Davis DR grading. 45° field of view: 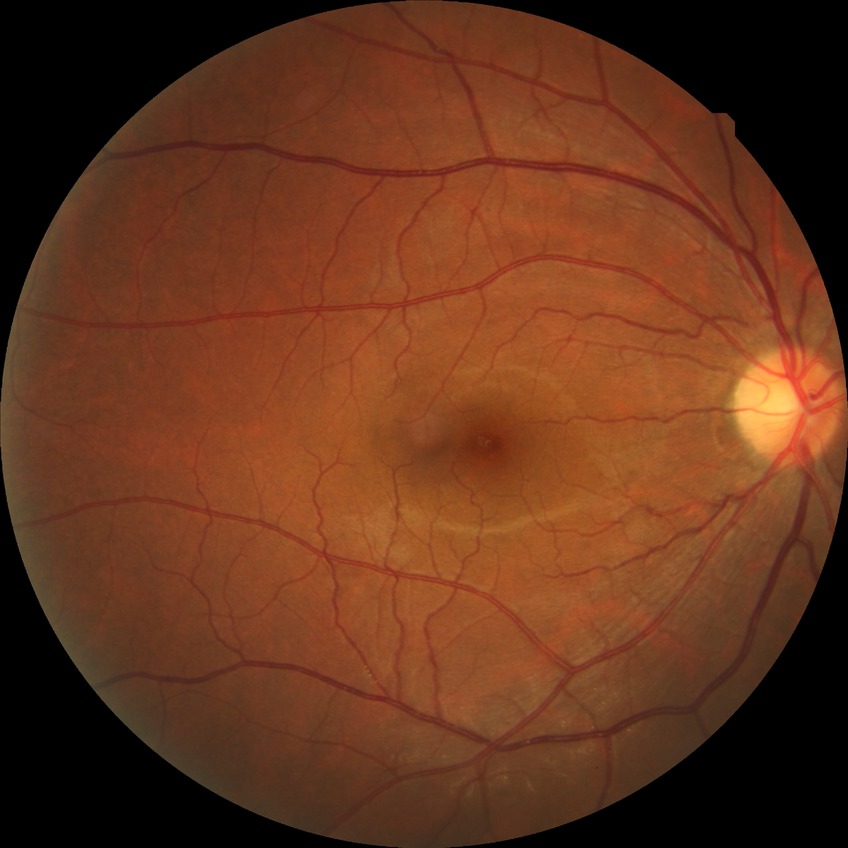

diabetic retinopathy severity: no diabetic retinopathy.